45-degree field of view.
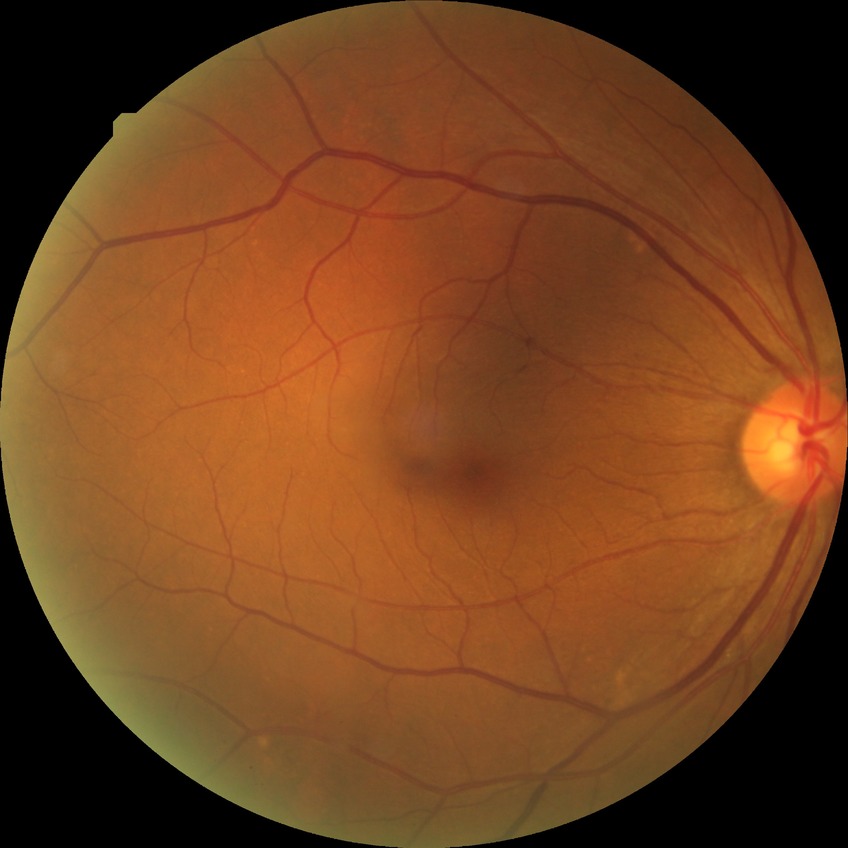 diabetic retinopathy (DR) = NDR (no diabetic retinopathy).